Infant wide-field fundus photograph
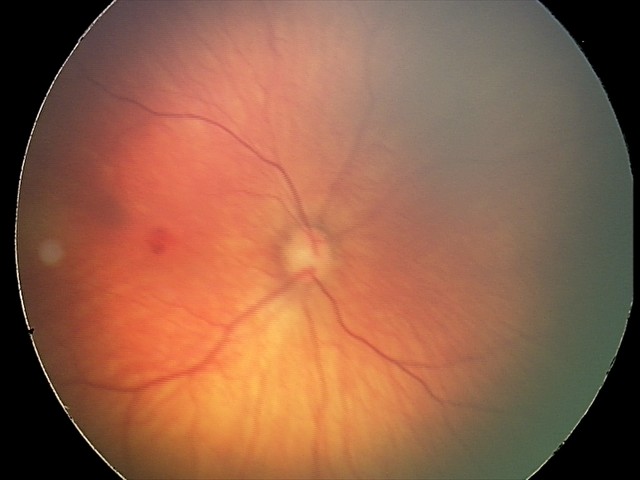 Screening examination consistent with retinal hemorrhages.